Wide-field fundus photograph from neonatal ROP screening.
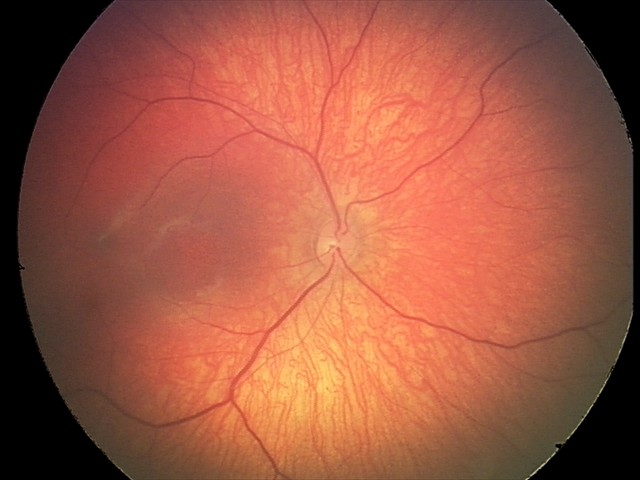
Examination diagnosed as retinal hemorrhages.